Centered on the optic disc, color fundus image: 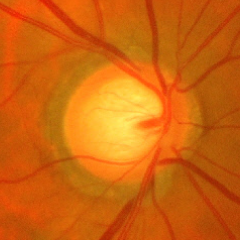
Findings consistent with glaucoma. Assessment = advanced glaucoma. Defined as near-total cupping of the optic nerve head, with or without severe visual field loss within the central 10 degrees of fixation.